100° field of view (Phoenix ICON); wide-field fundus photograph of an infant
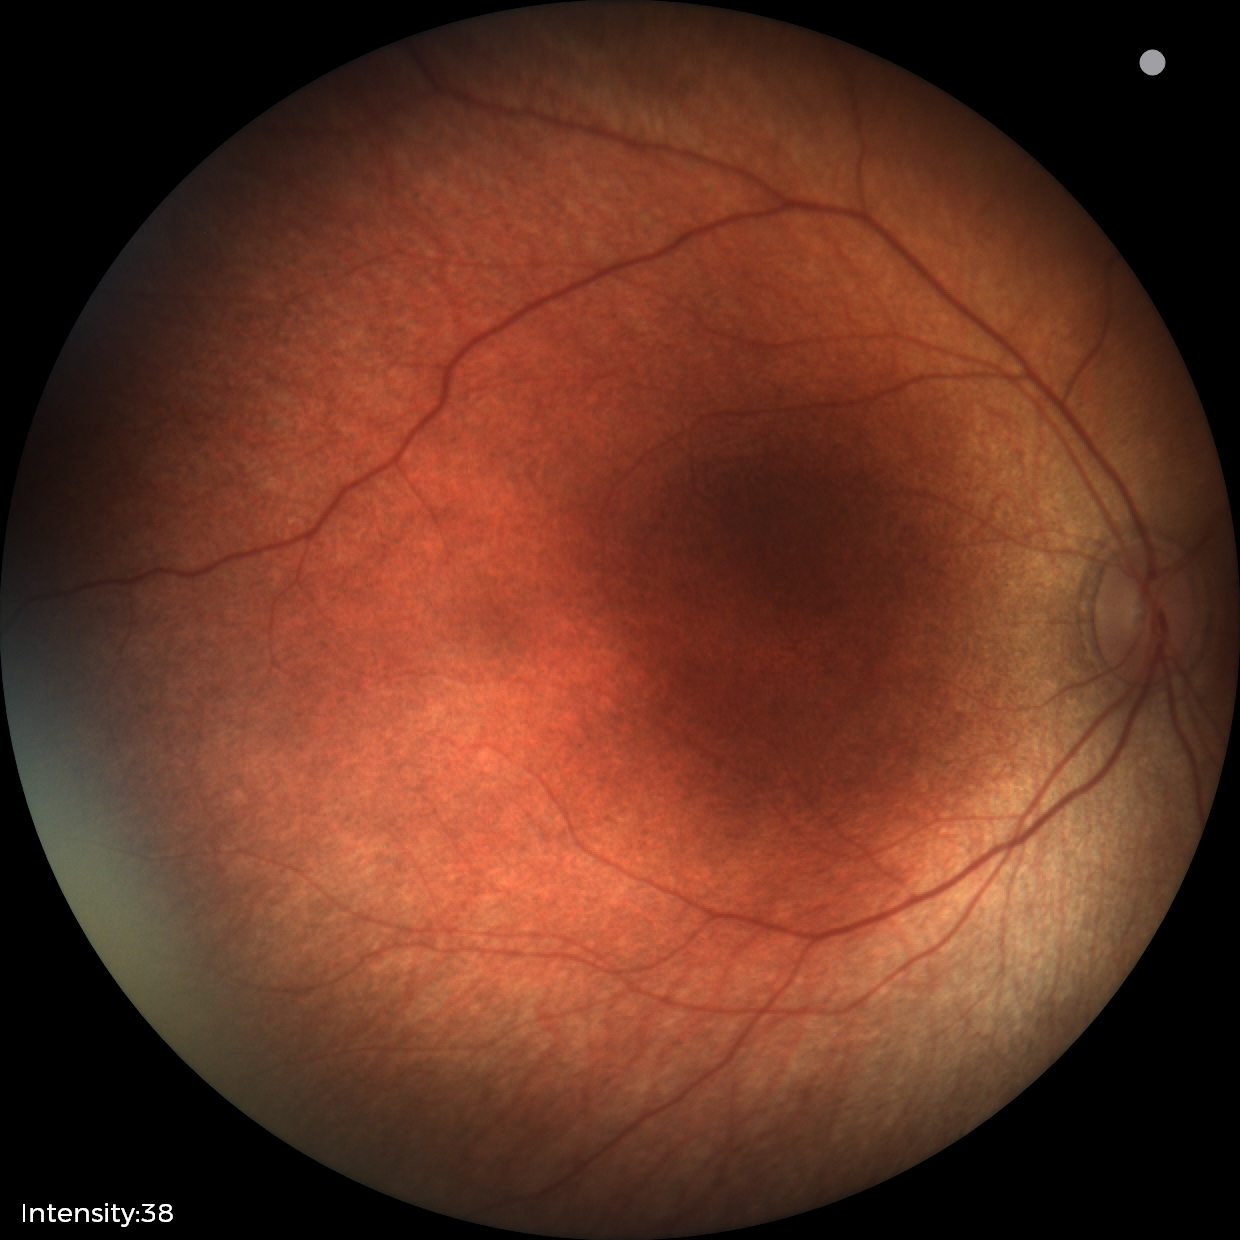
Examination with physiological retinal findings.